Image size 2048x1536, 45° FOV
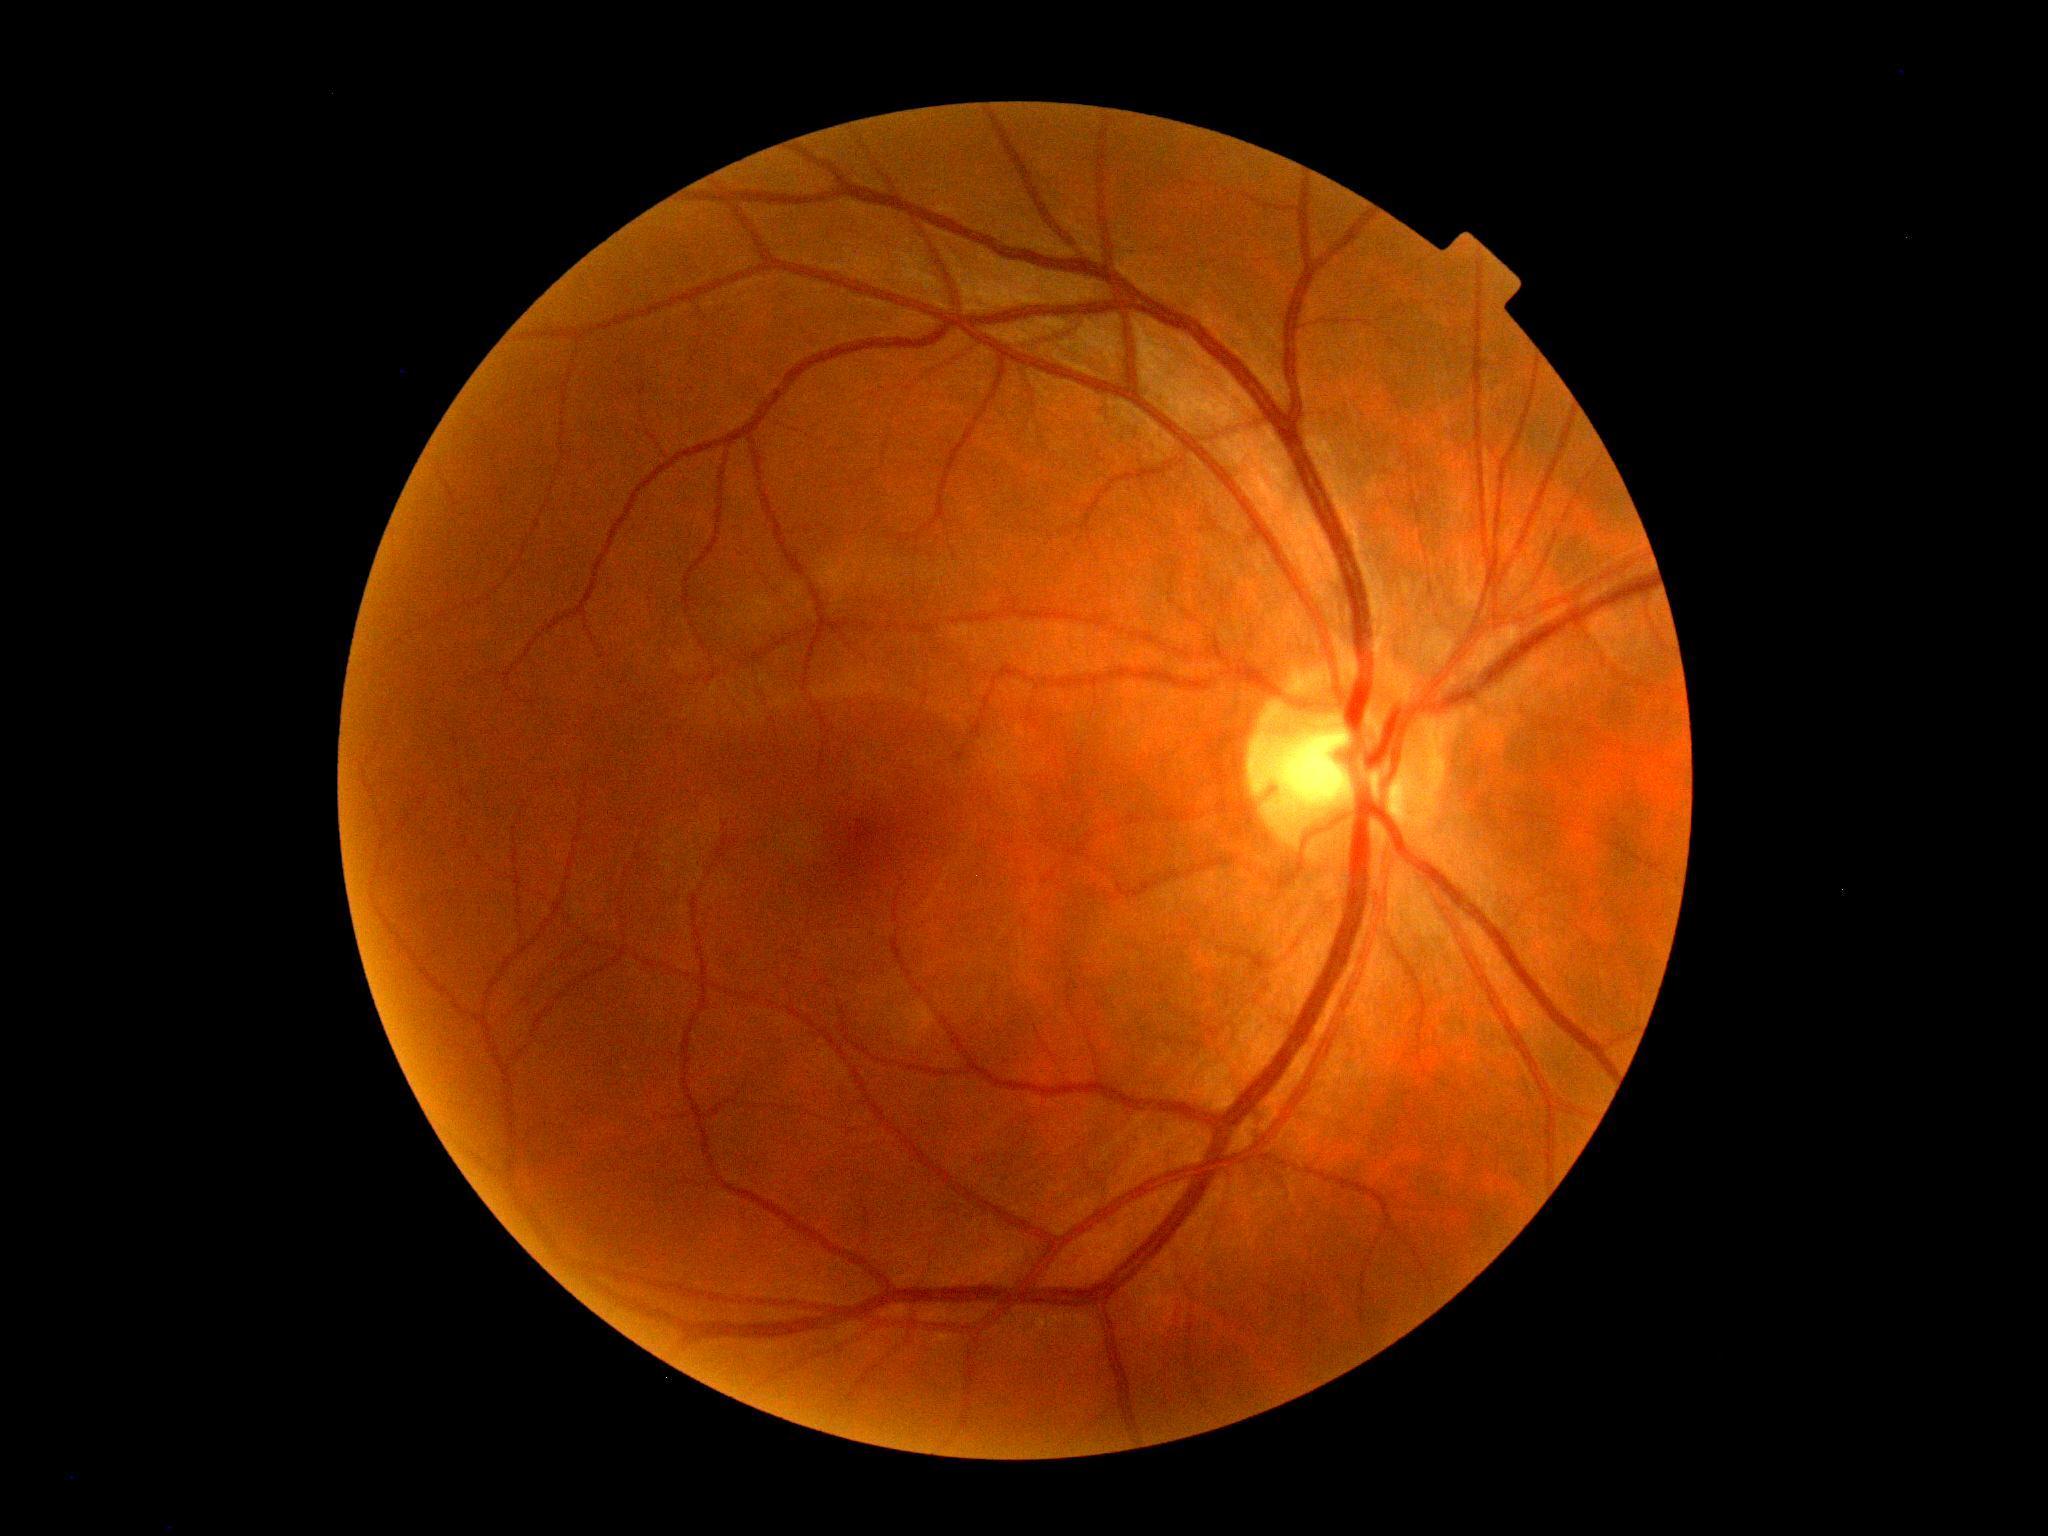

diabetic retinopathy severity: grade 0 (no apparent retinopathy).